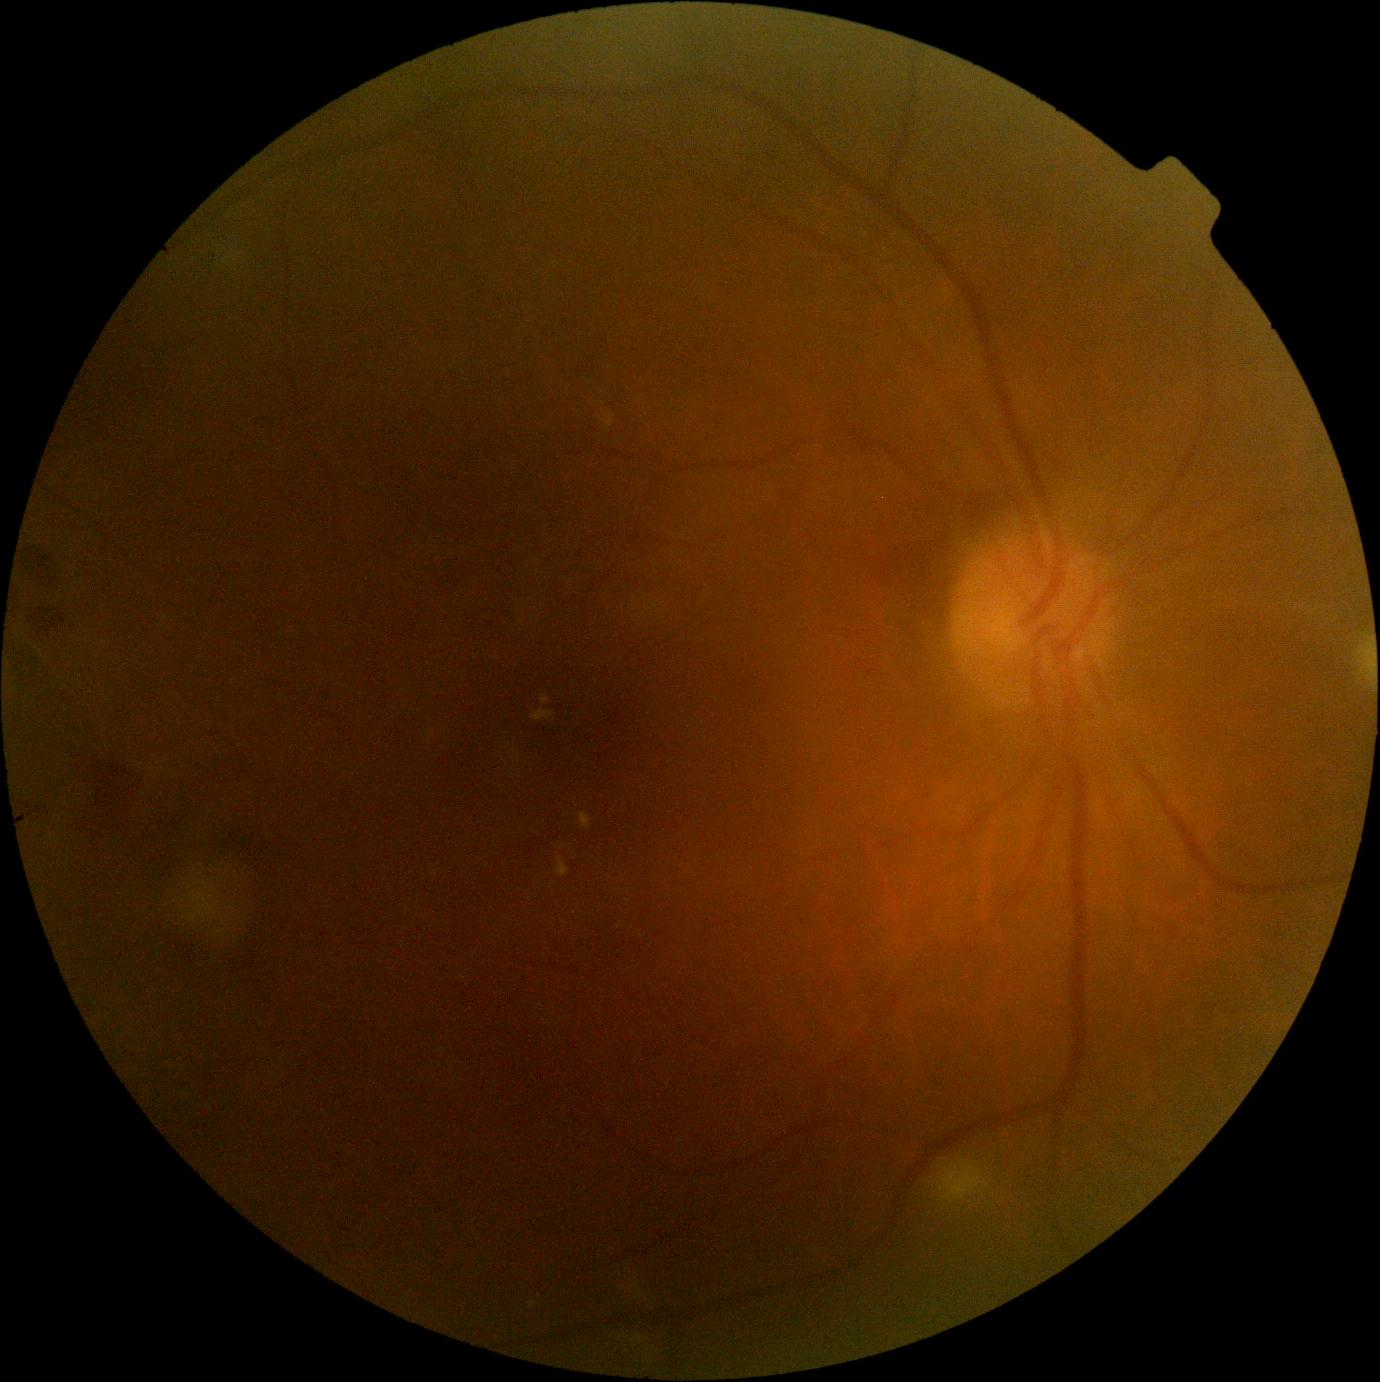
DR severity is grade 2 (moderate NPDR).